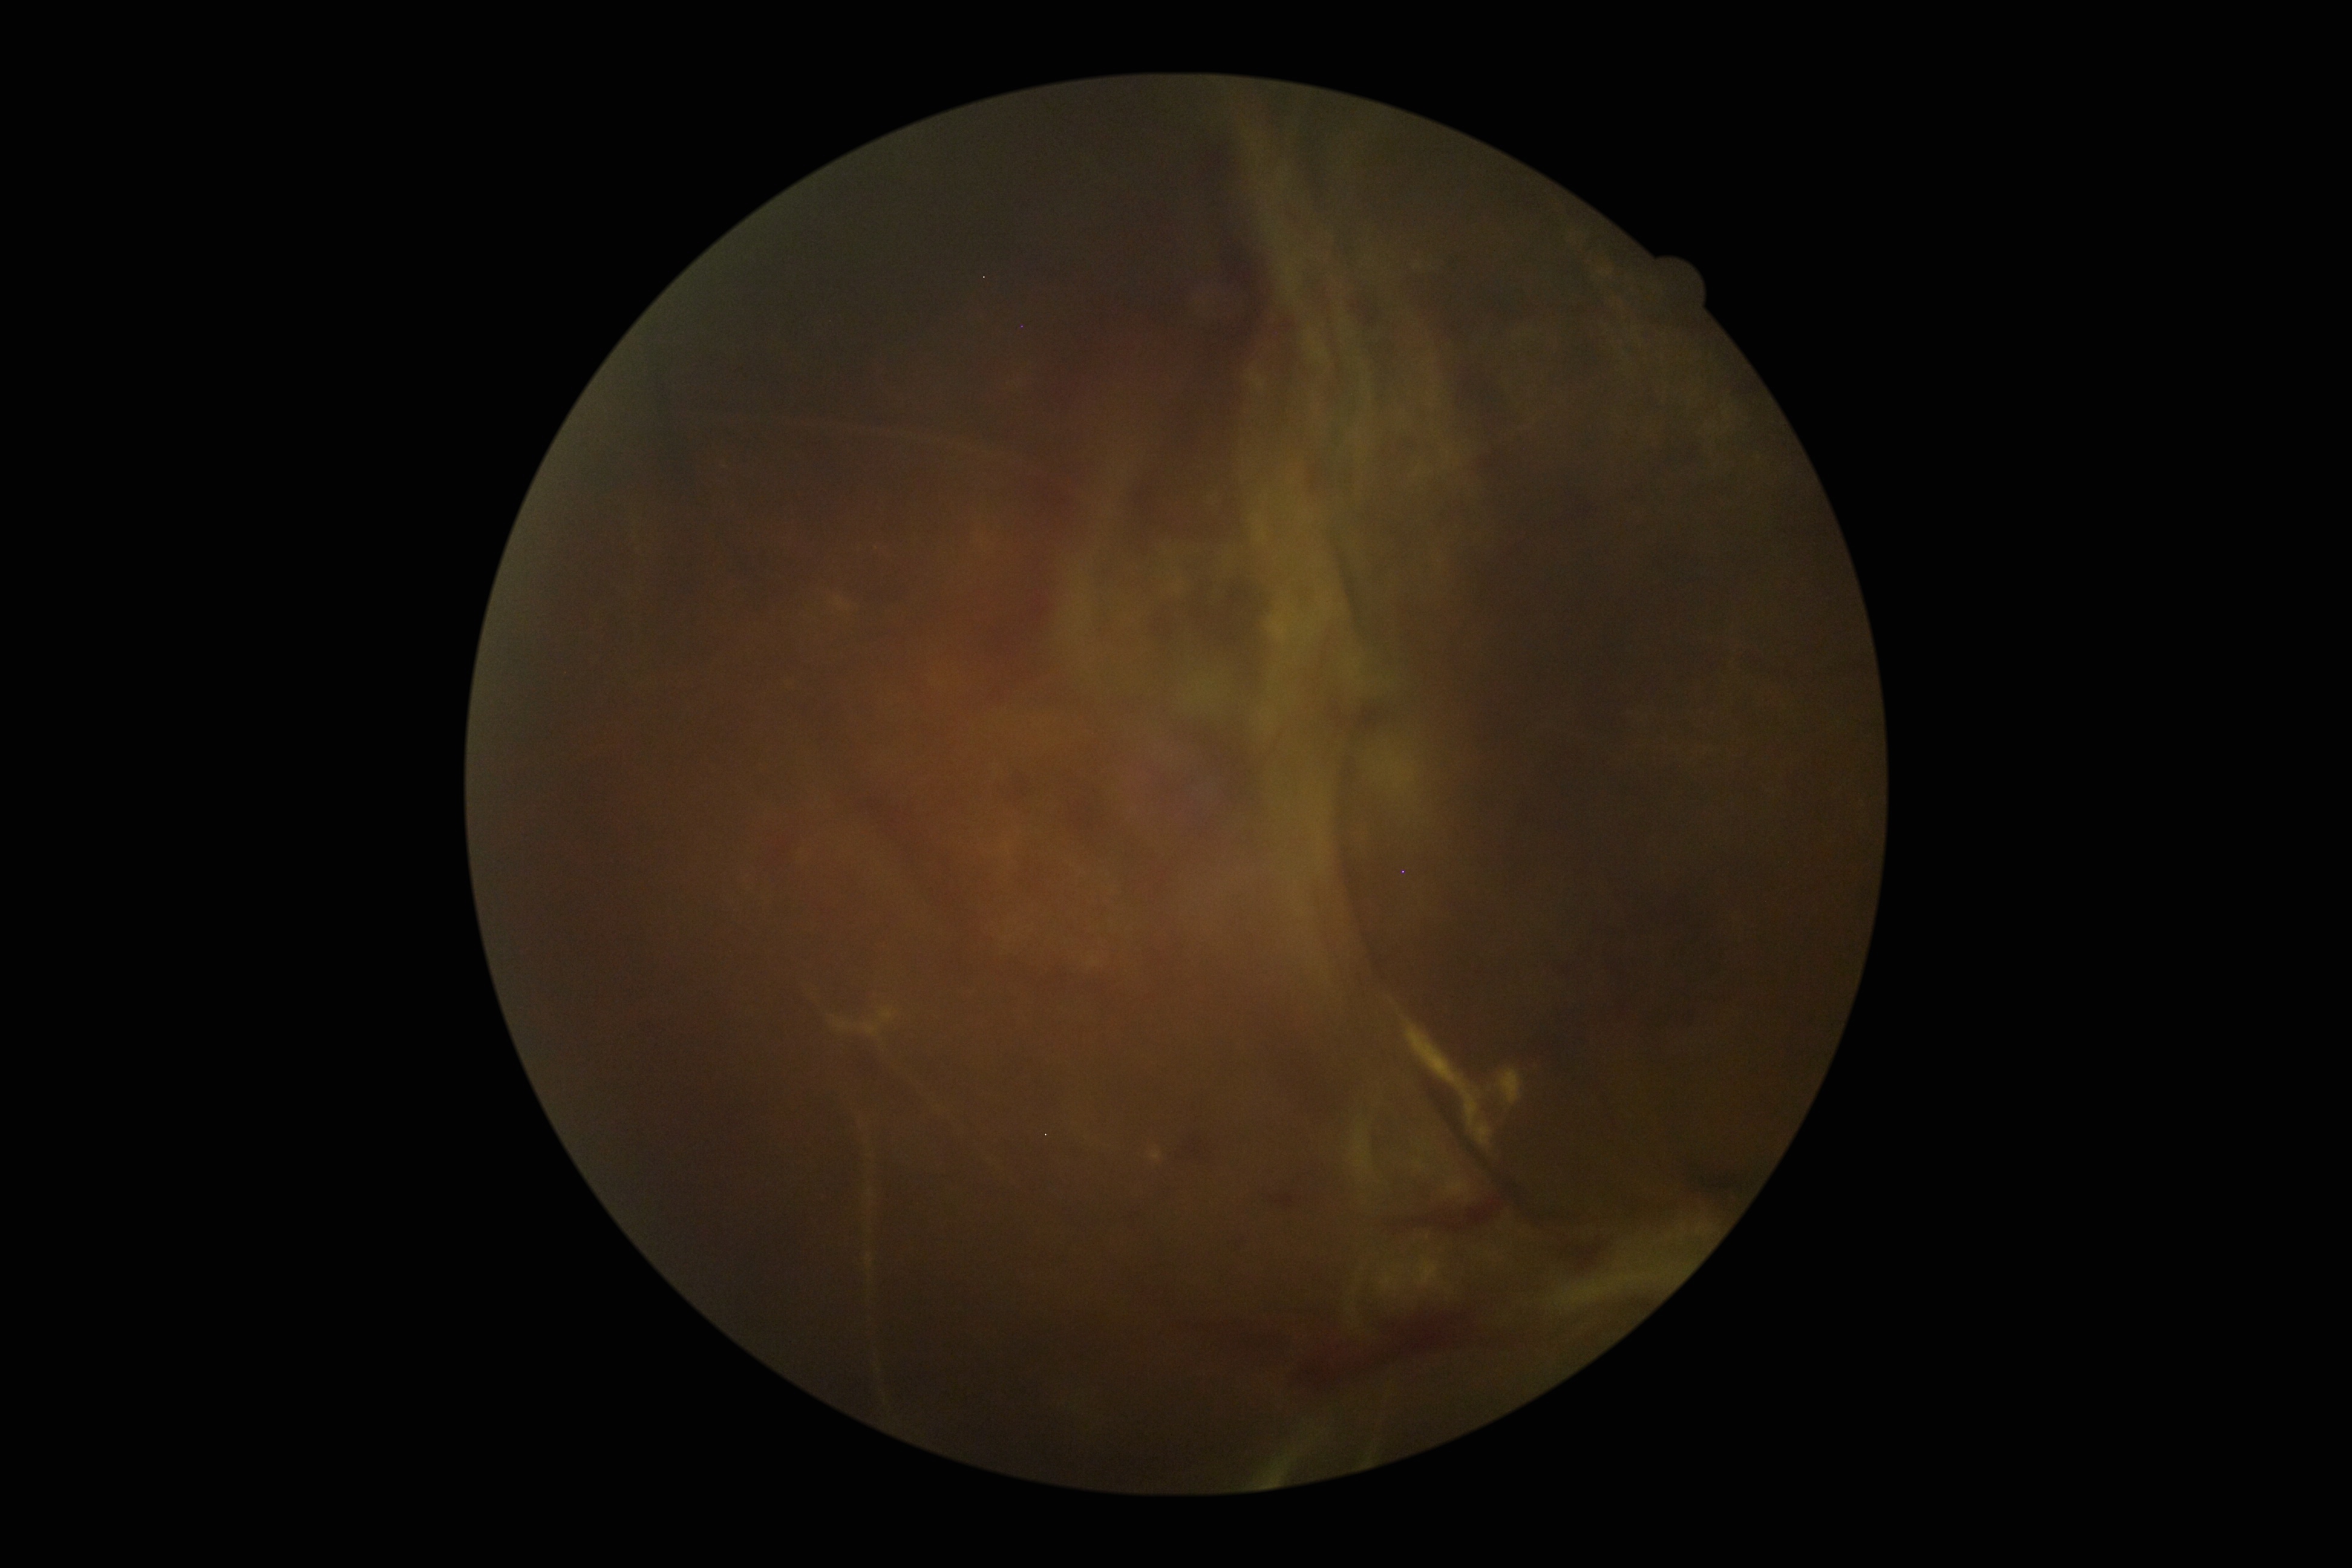

DR severity: 4.